Phoenix ICON, 100° FOV; wide-field fundus photograph from neonatal ROP screening:
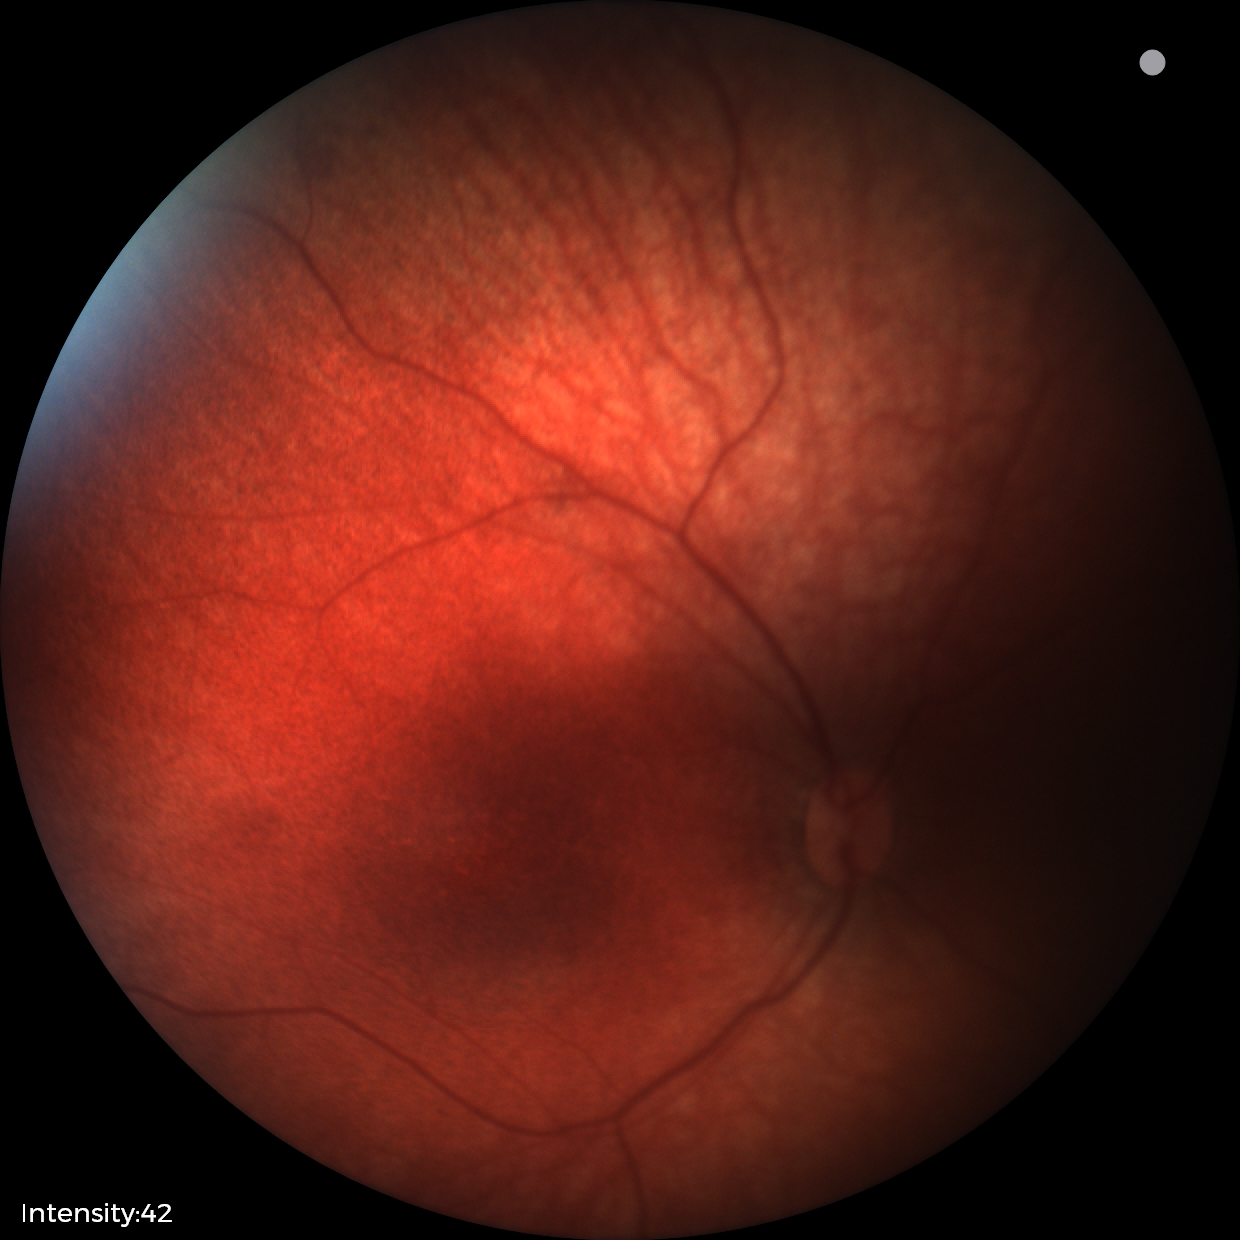

Screening diagnosis: normal retinal appearance.